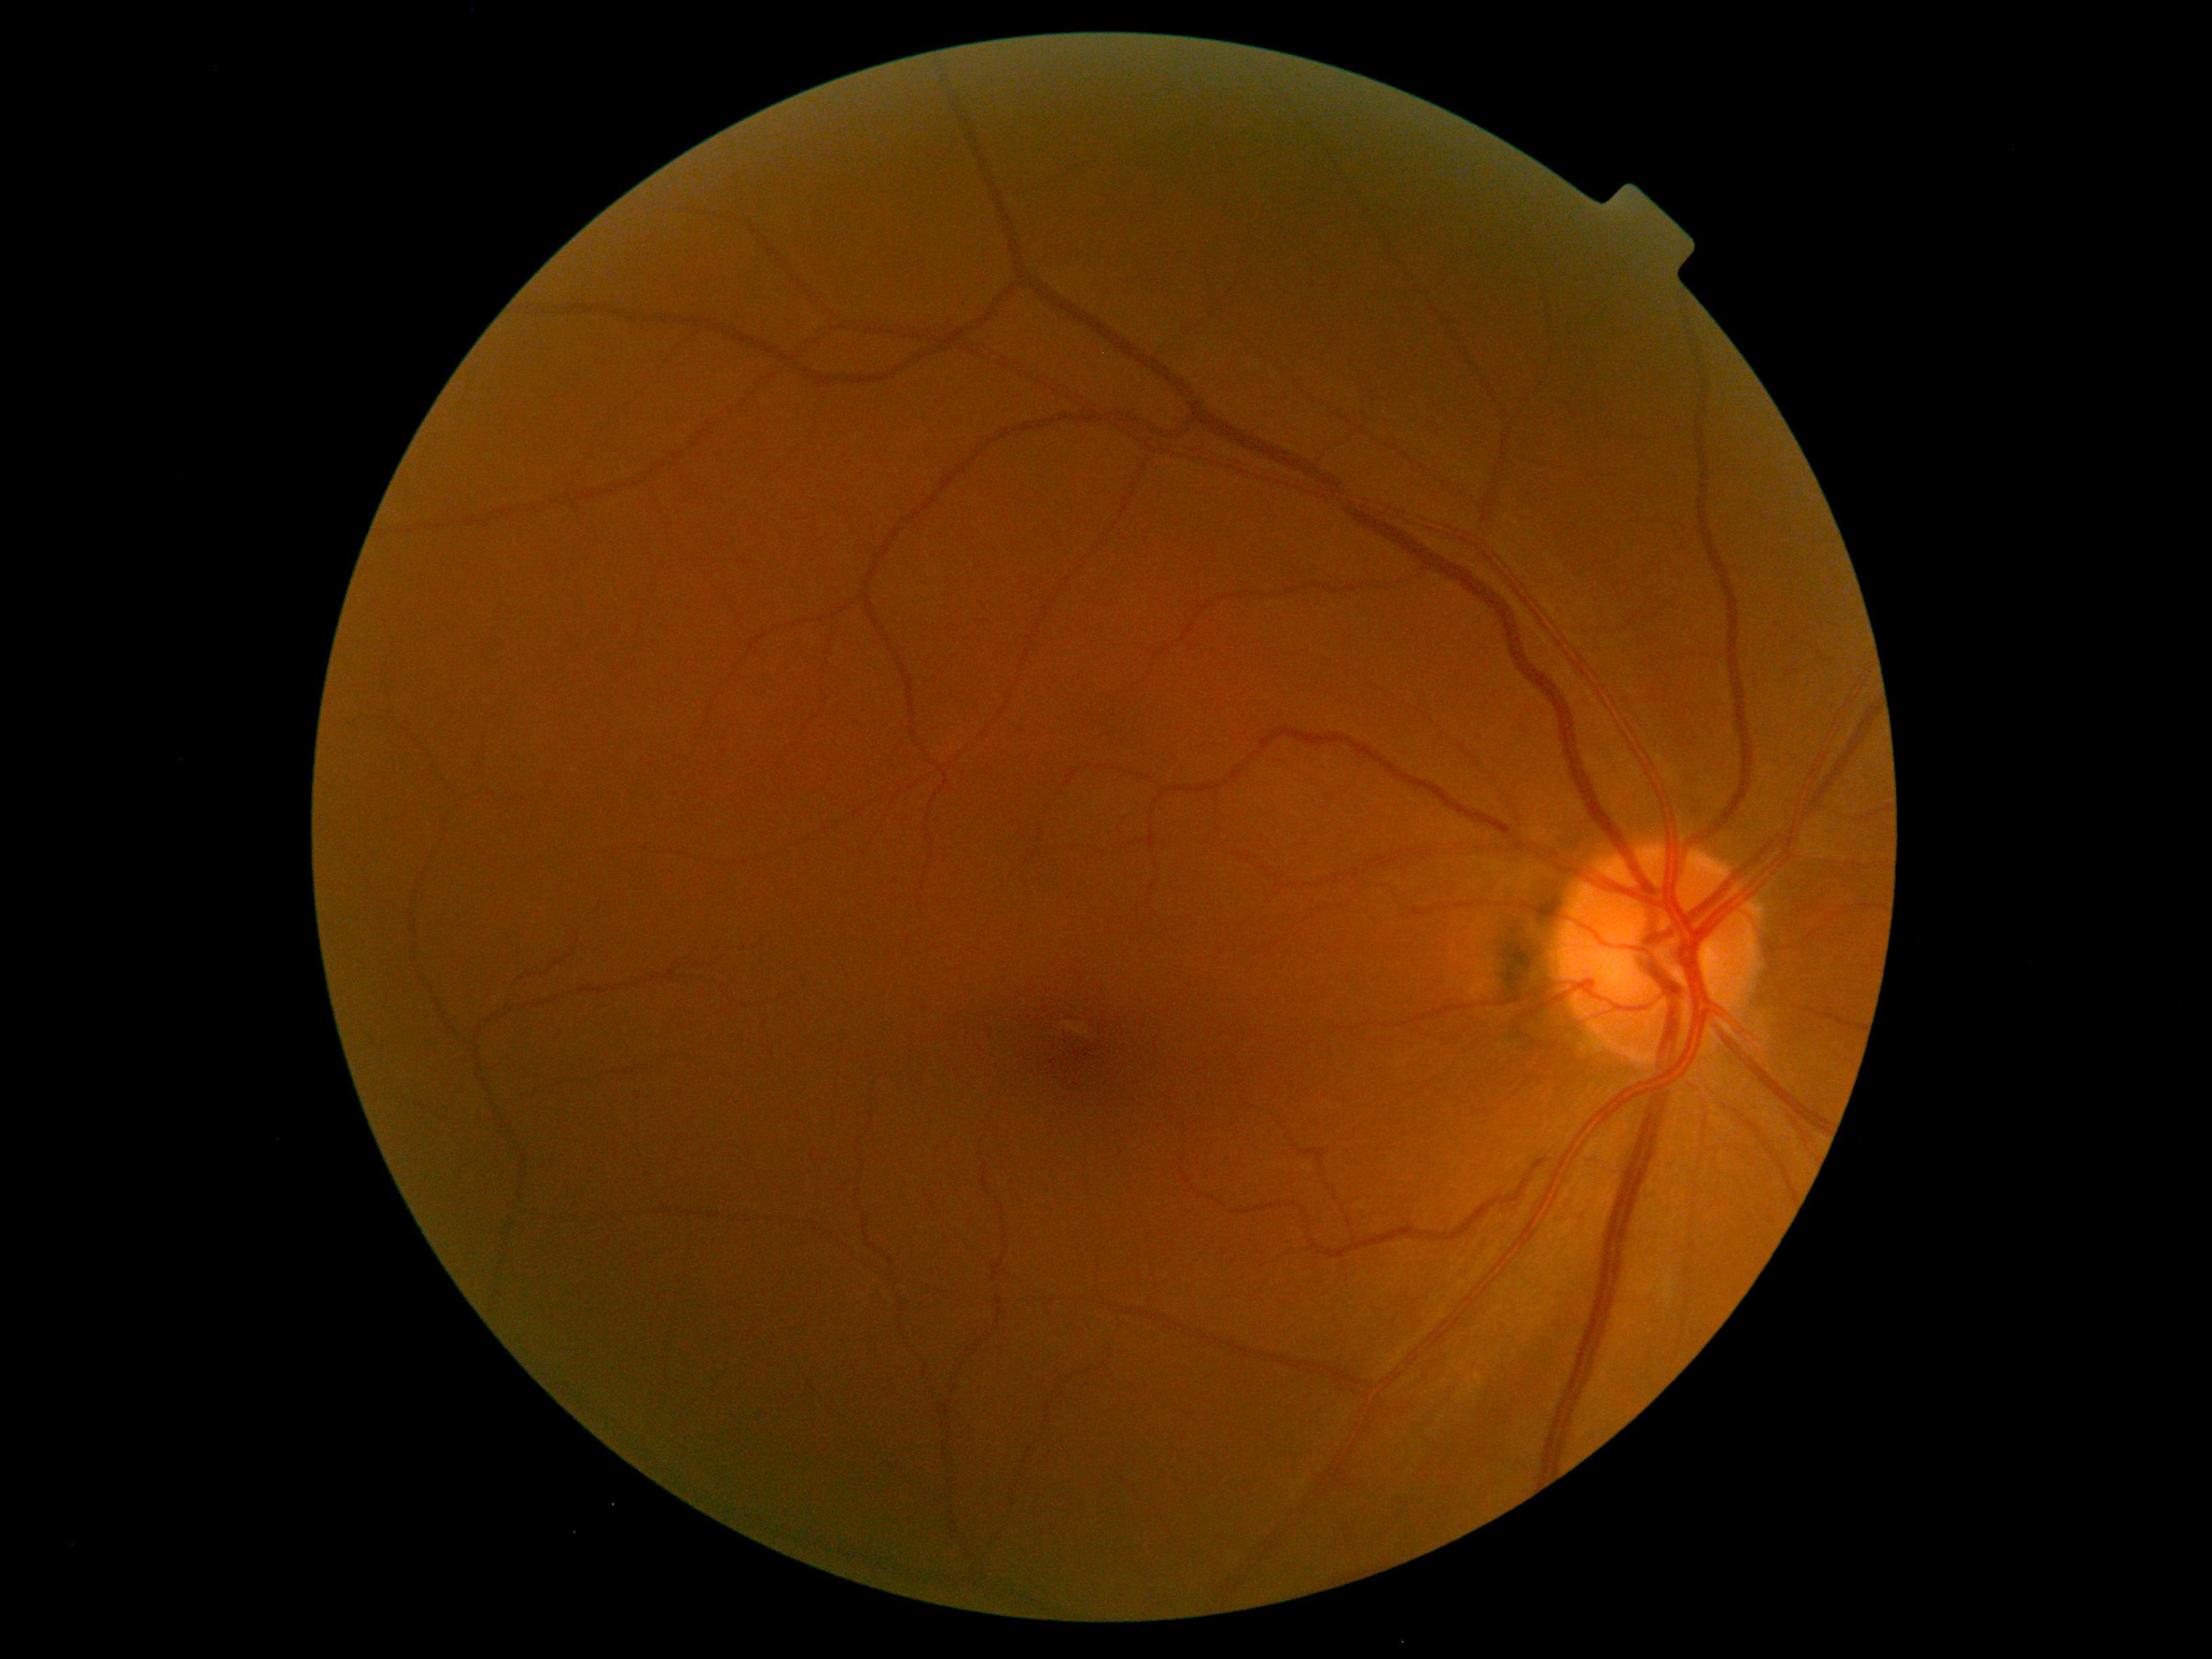

DR severity: grade 0 (no apparent retinopathy).